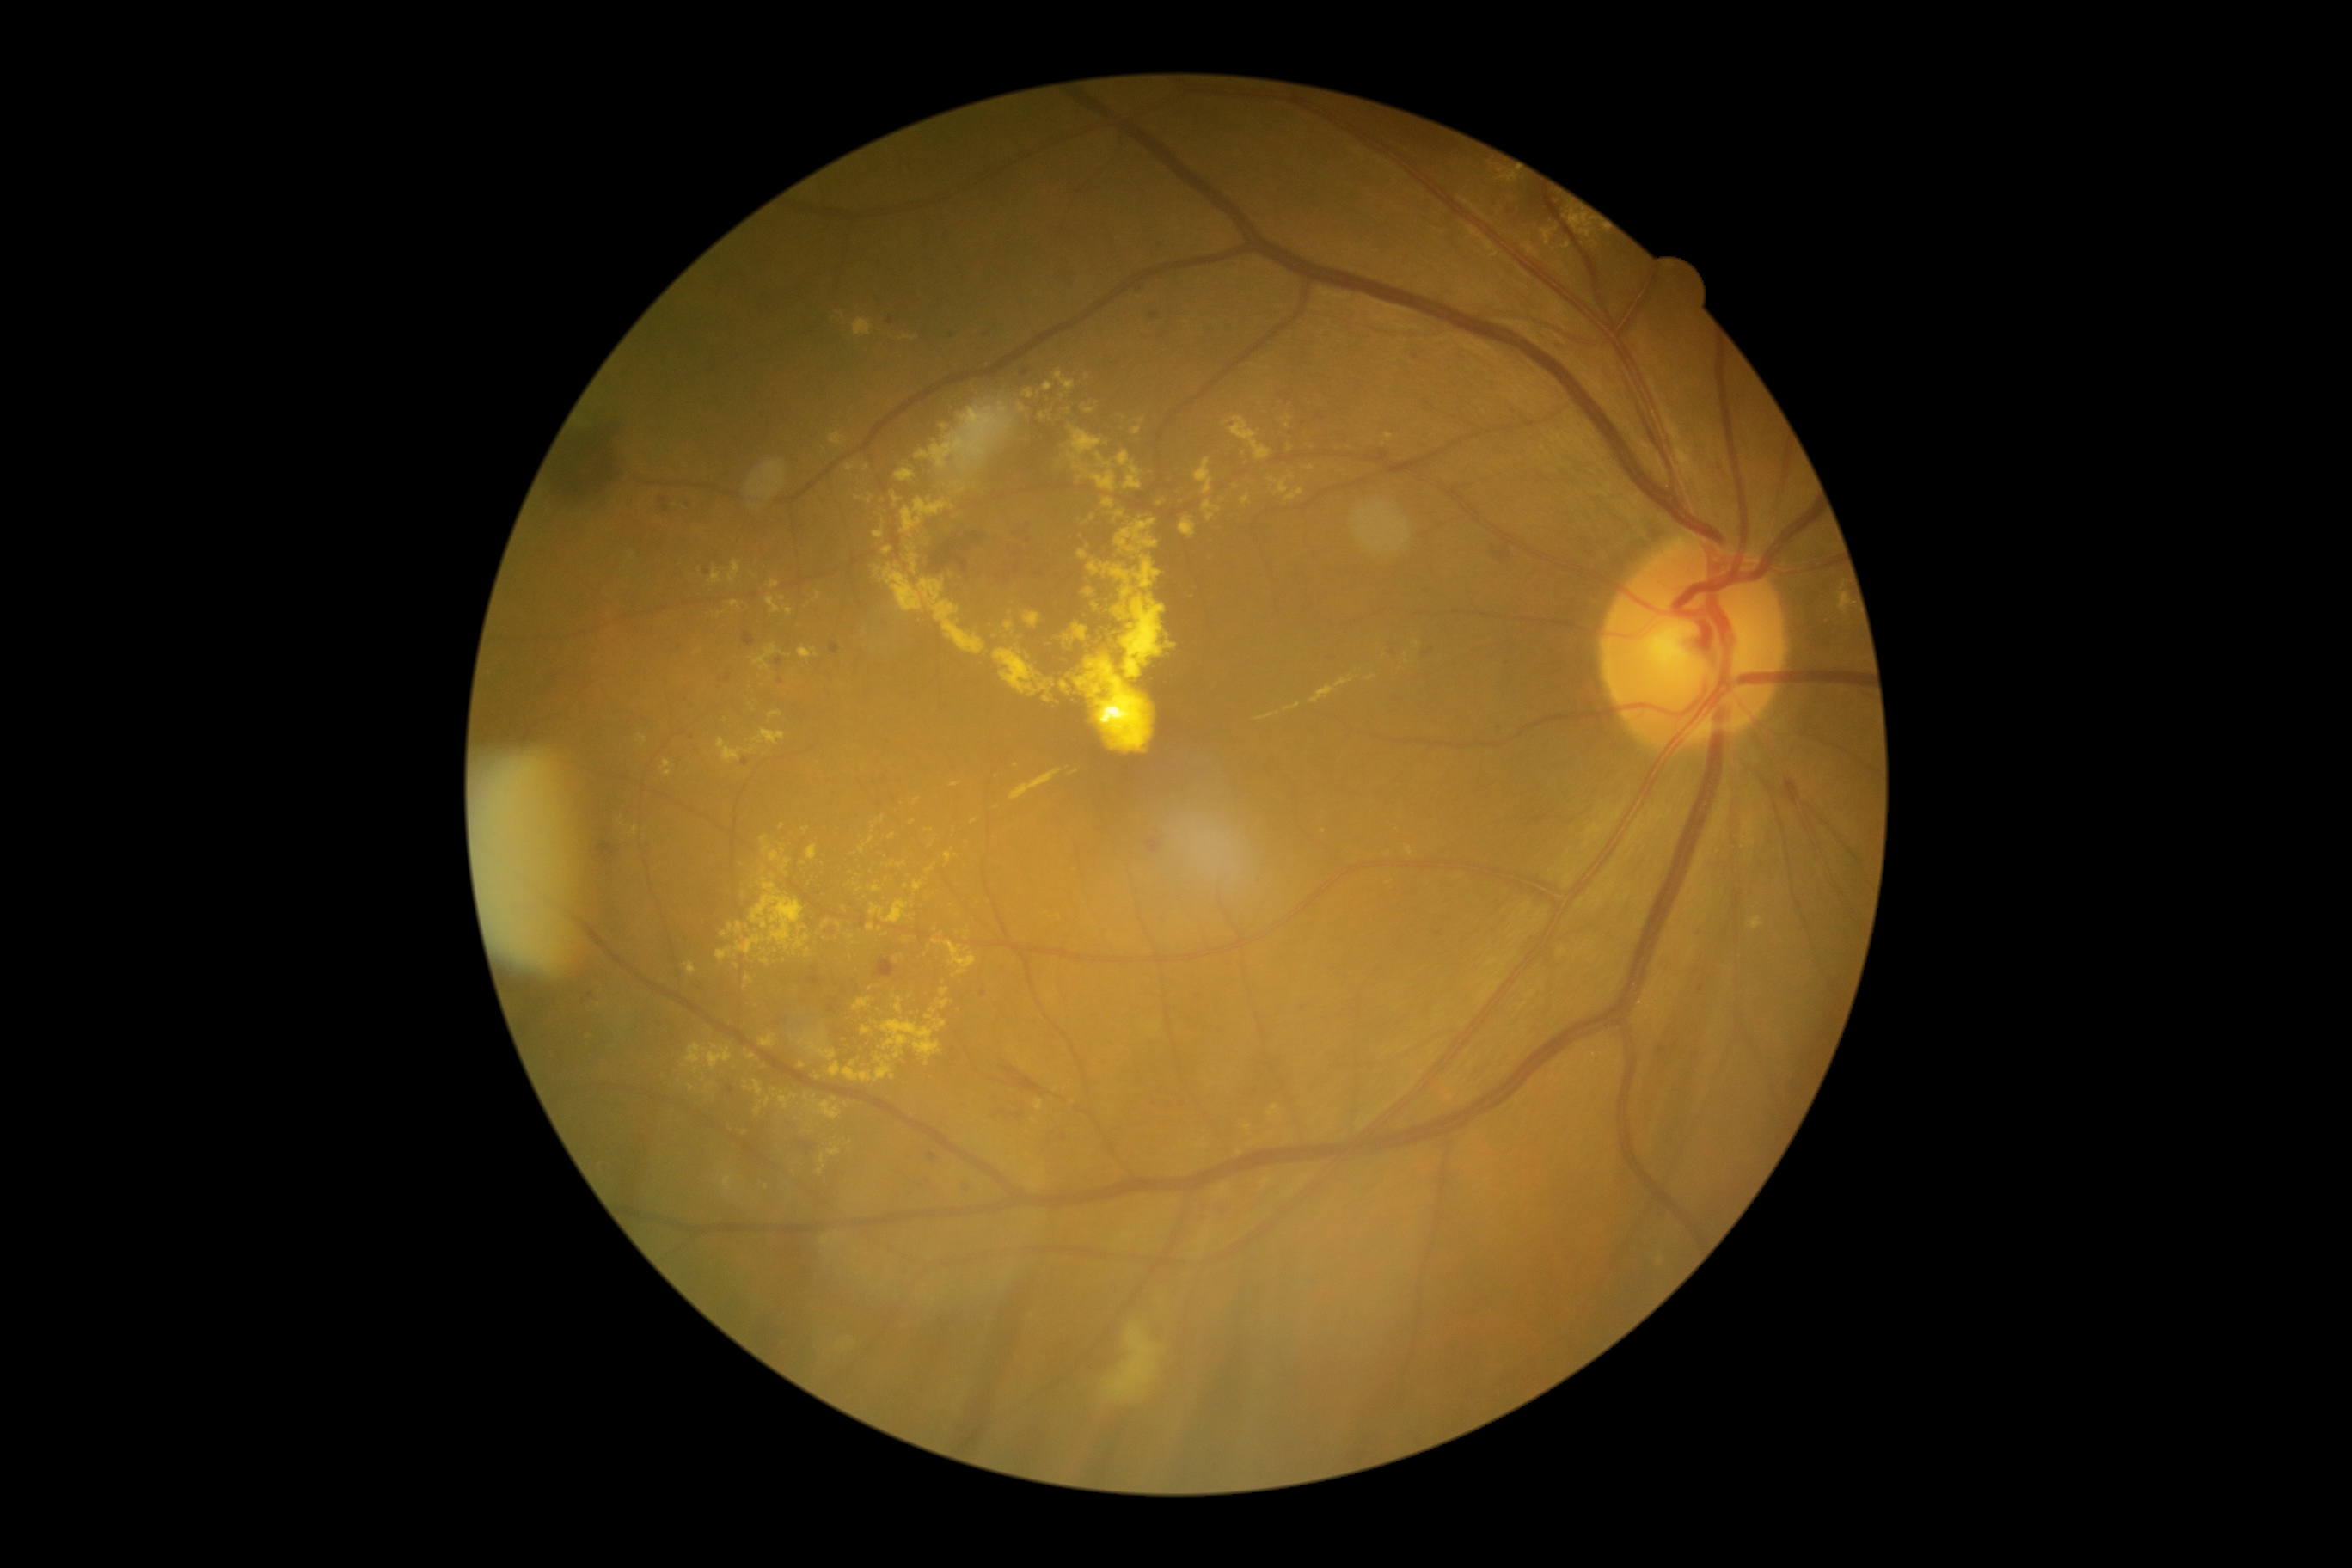 Findings:
- diabetic retinopathy — grade 2